45° field of view: 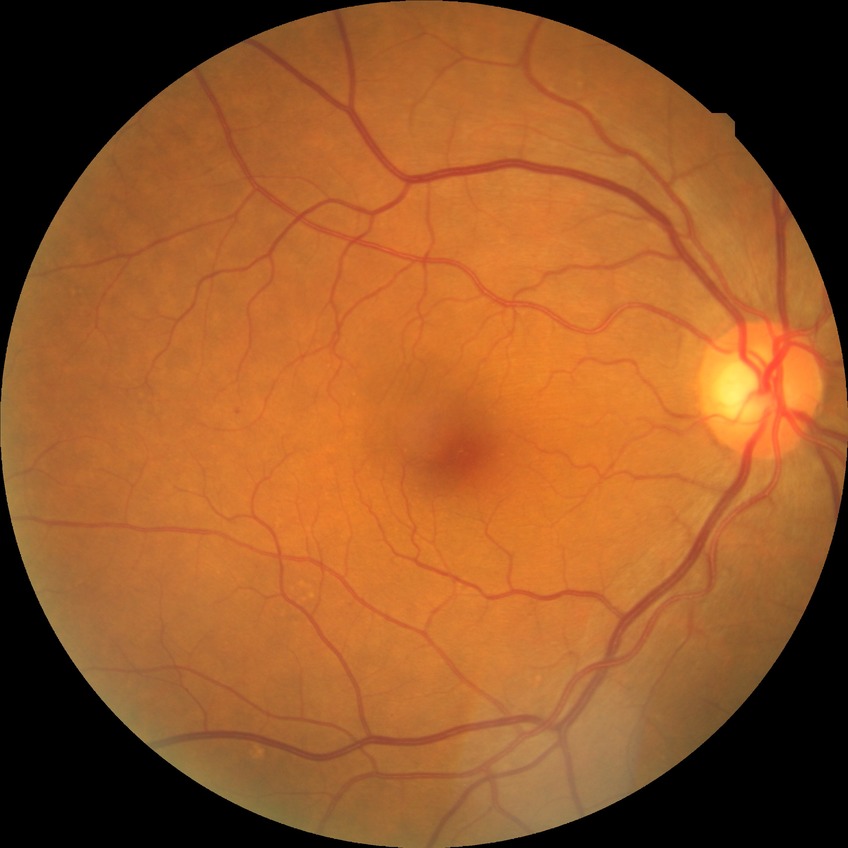 Diabetic retinopathy (DR) is no diabetic retinopathy (NDR).